Infant wide-field fundus photograph.
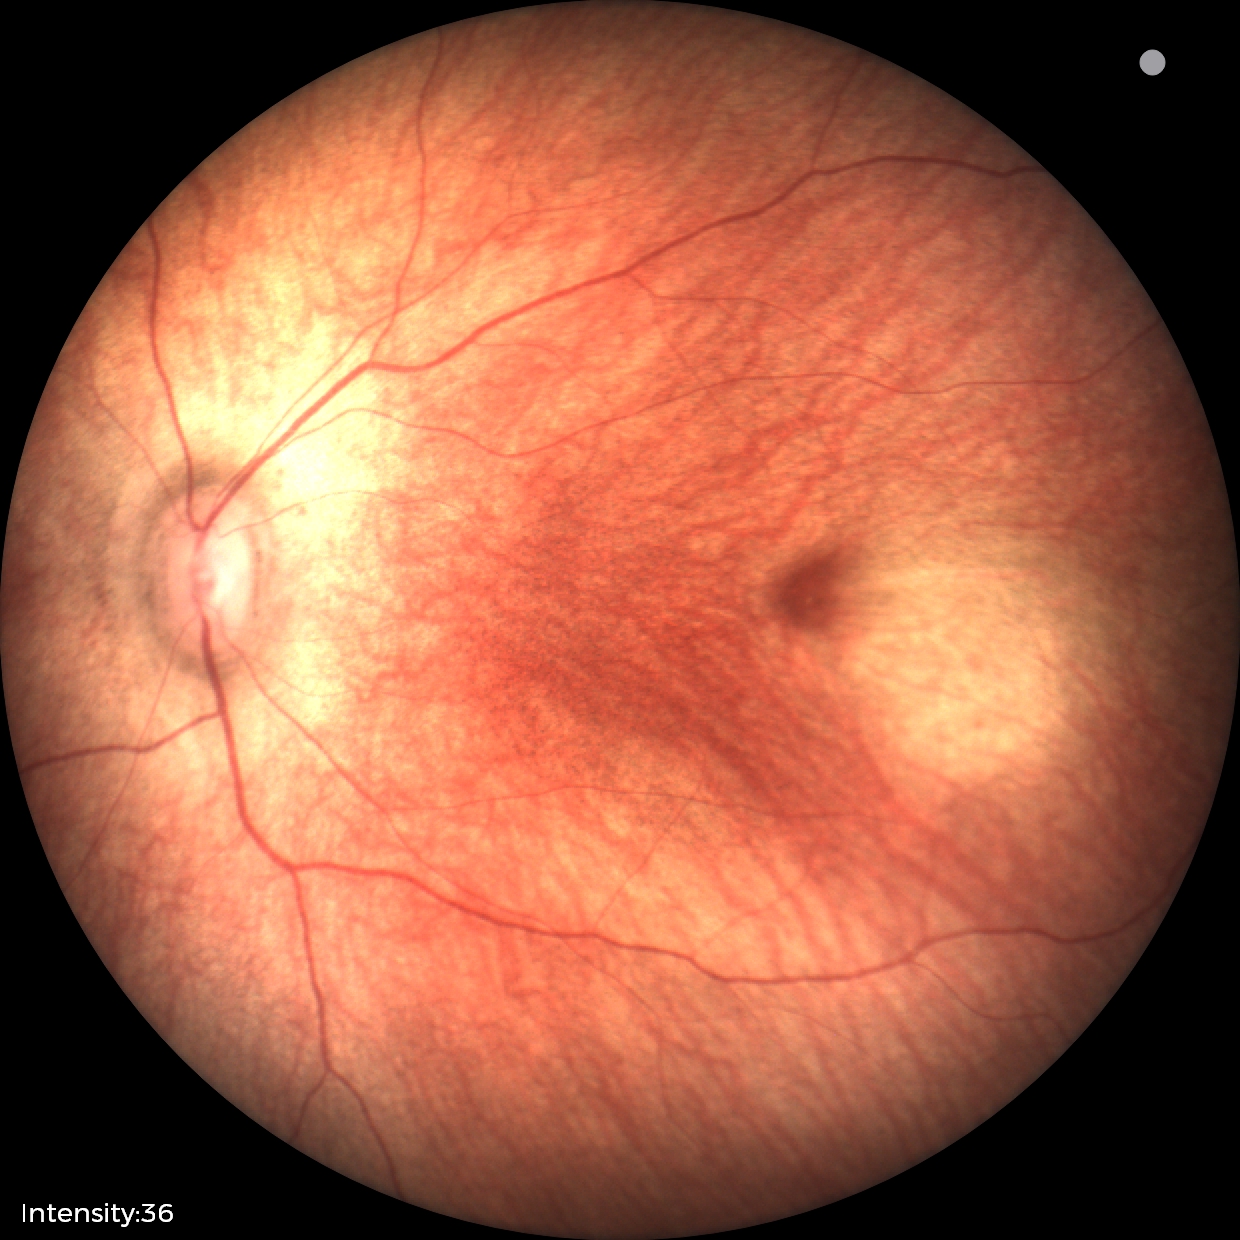 Q: What is the screening diagnosis?
A: physiological finding